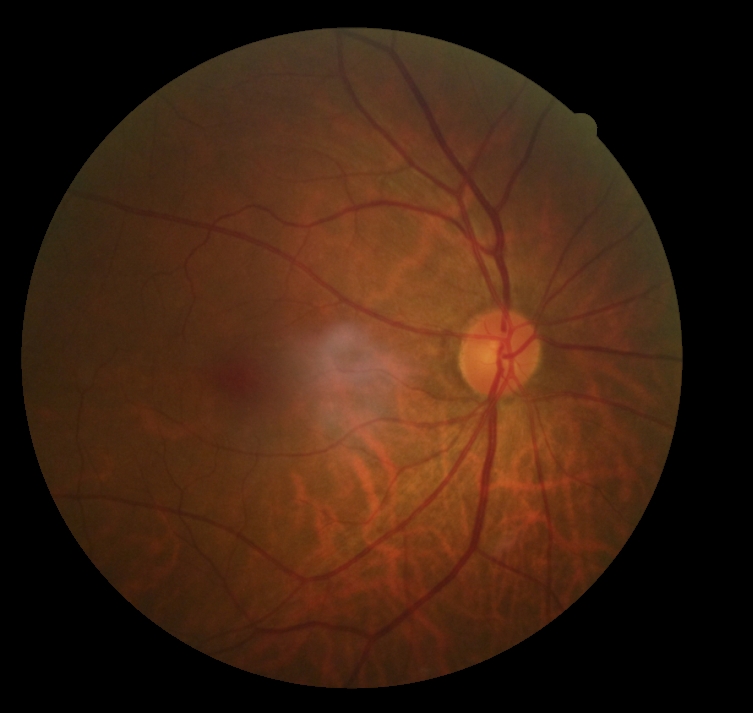 Diabetic retinopathy (DR): no apparent retinopathy (grade 0).